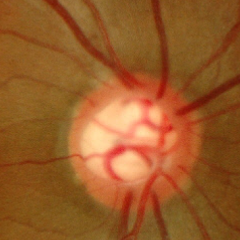 No glaucoma.